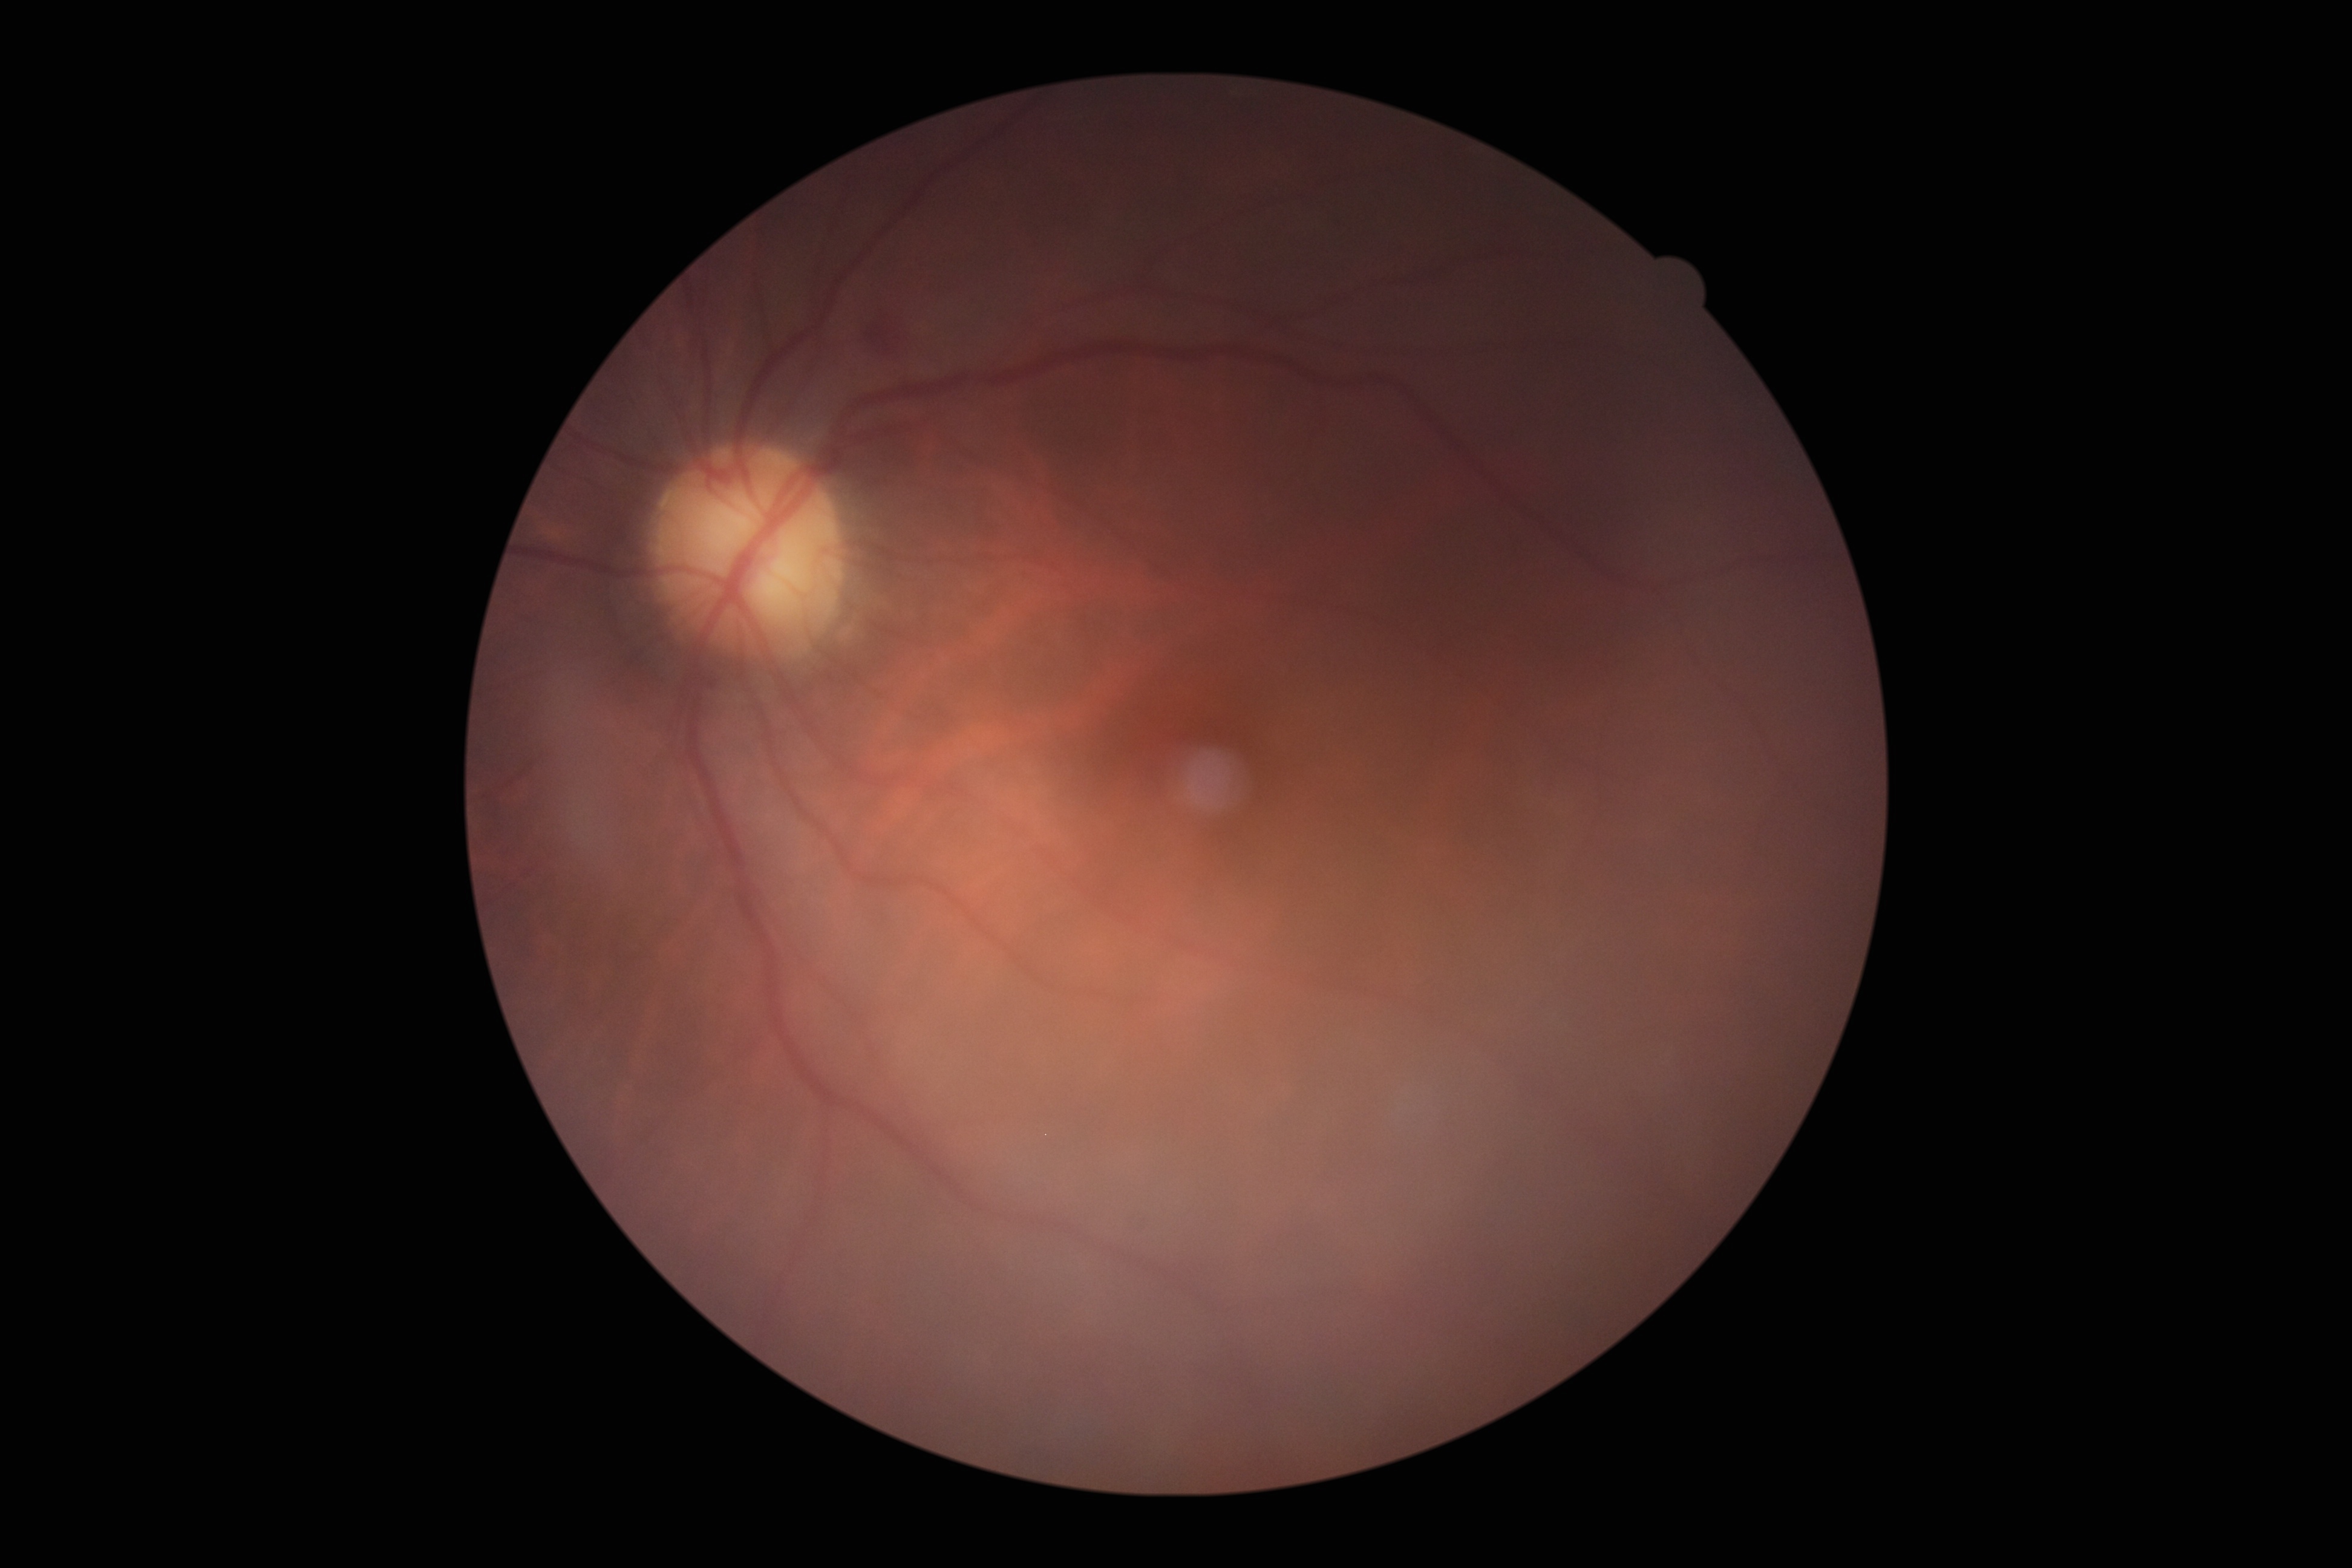

DR stage is grade 2 (moderate NPDR). DR class: non-proliferative diabetic retinopathy.